Pediatric retinal photograph (wide-field); 100° field of view (Phoenix ICON):
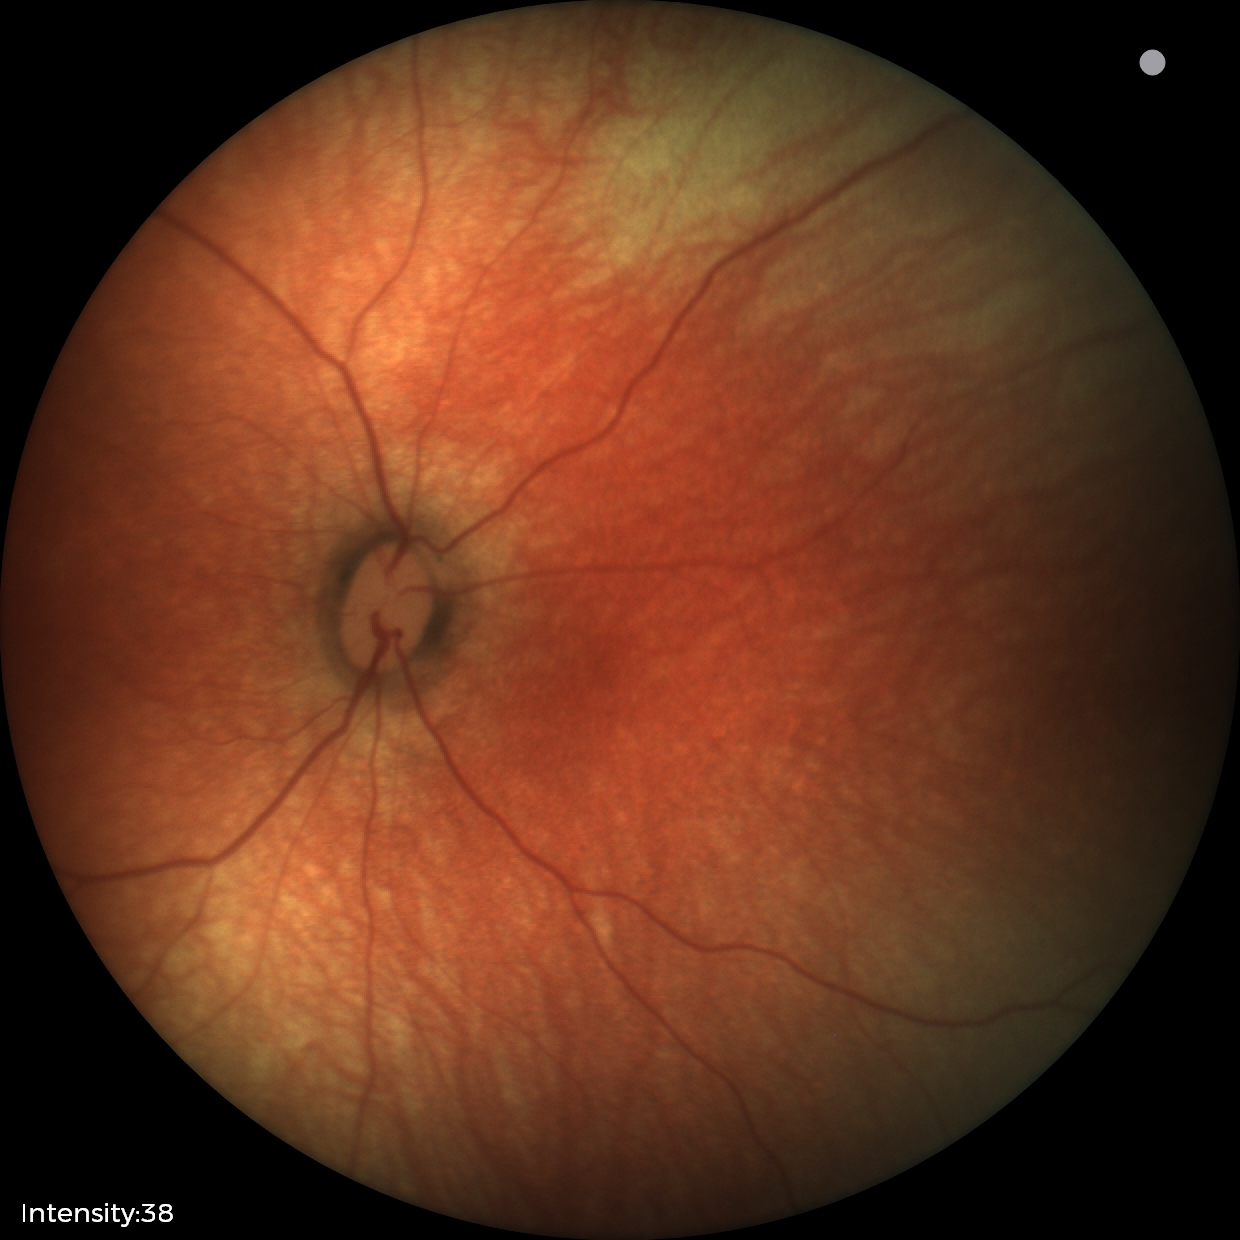 Diagnosis = physiological appearance.